Non-mydriatic fundus camera · cropped to the optic nerve head
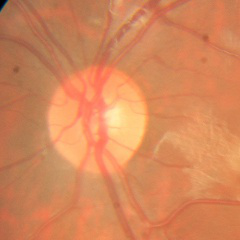
Q: Glaucoma assessment?
A: No — no glaucomatous changes.